2352 x 1568 pixels, fundus photo, 45° FOV
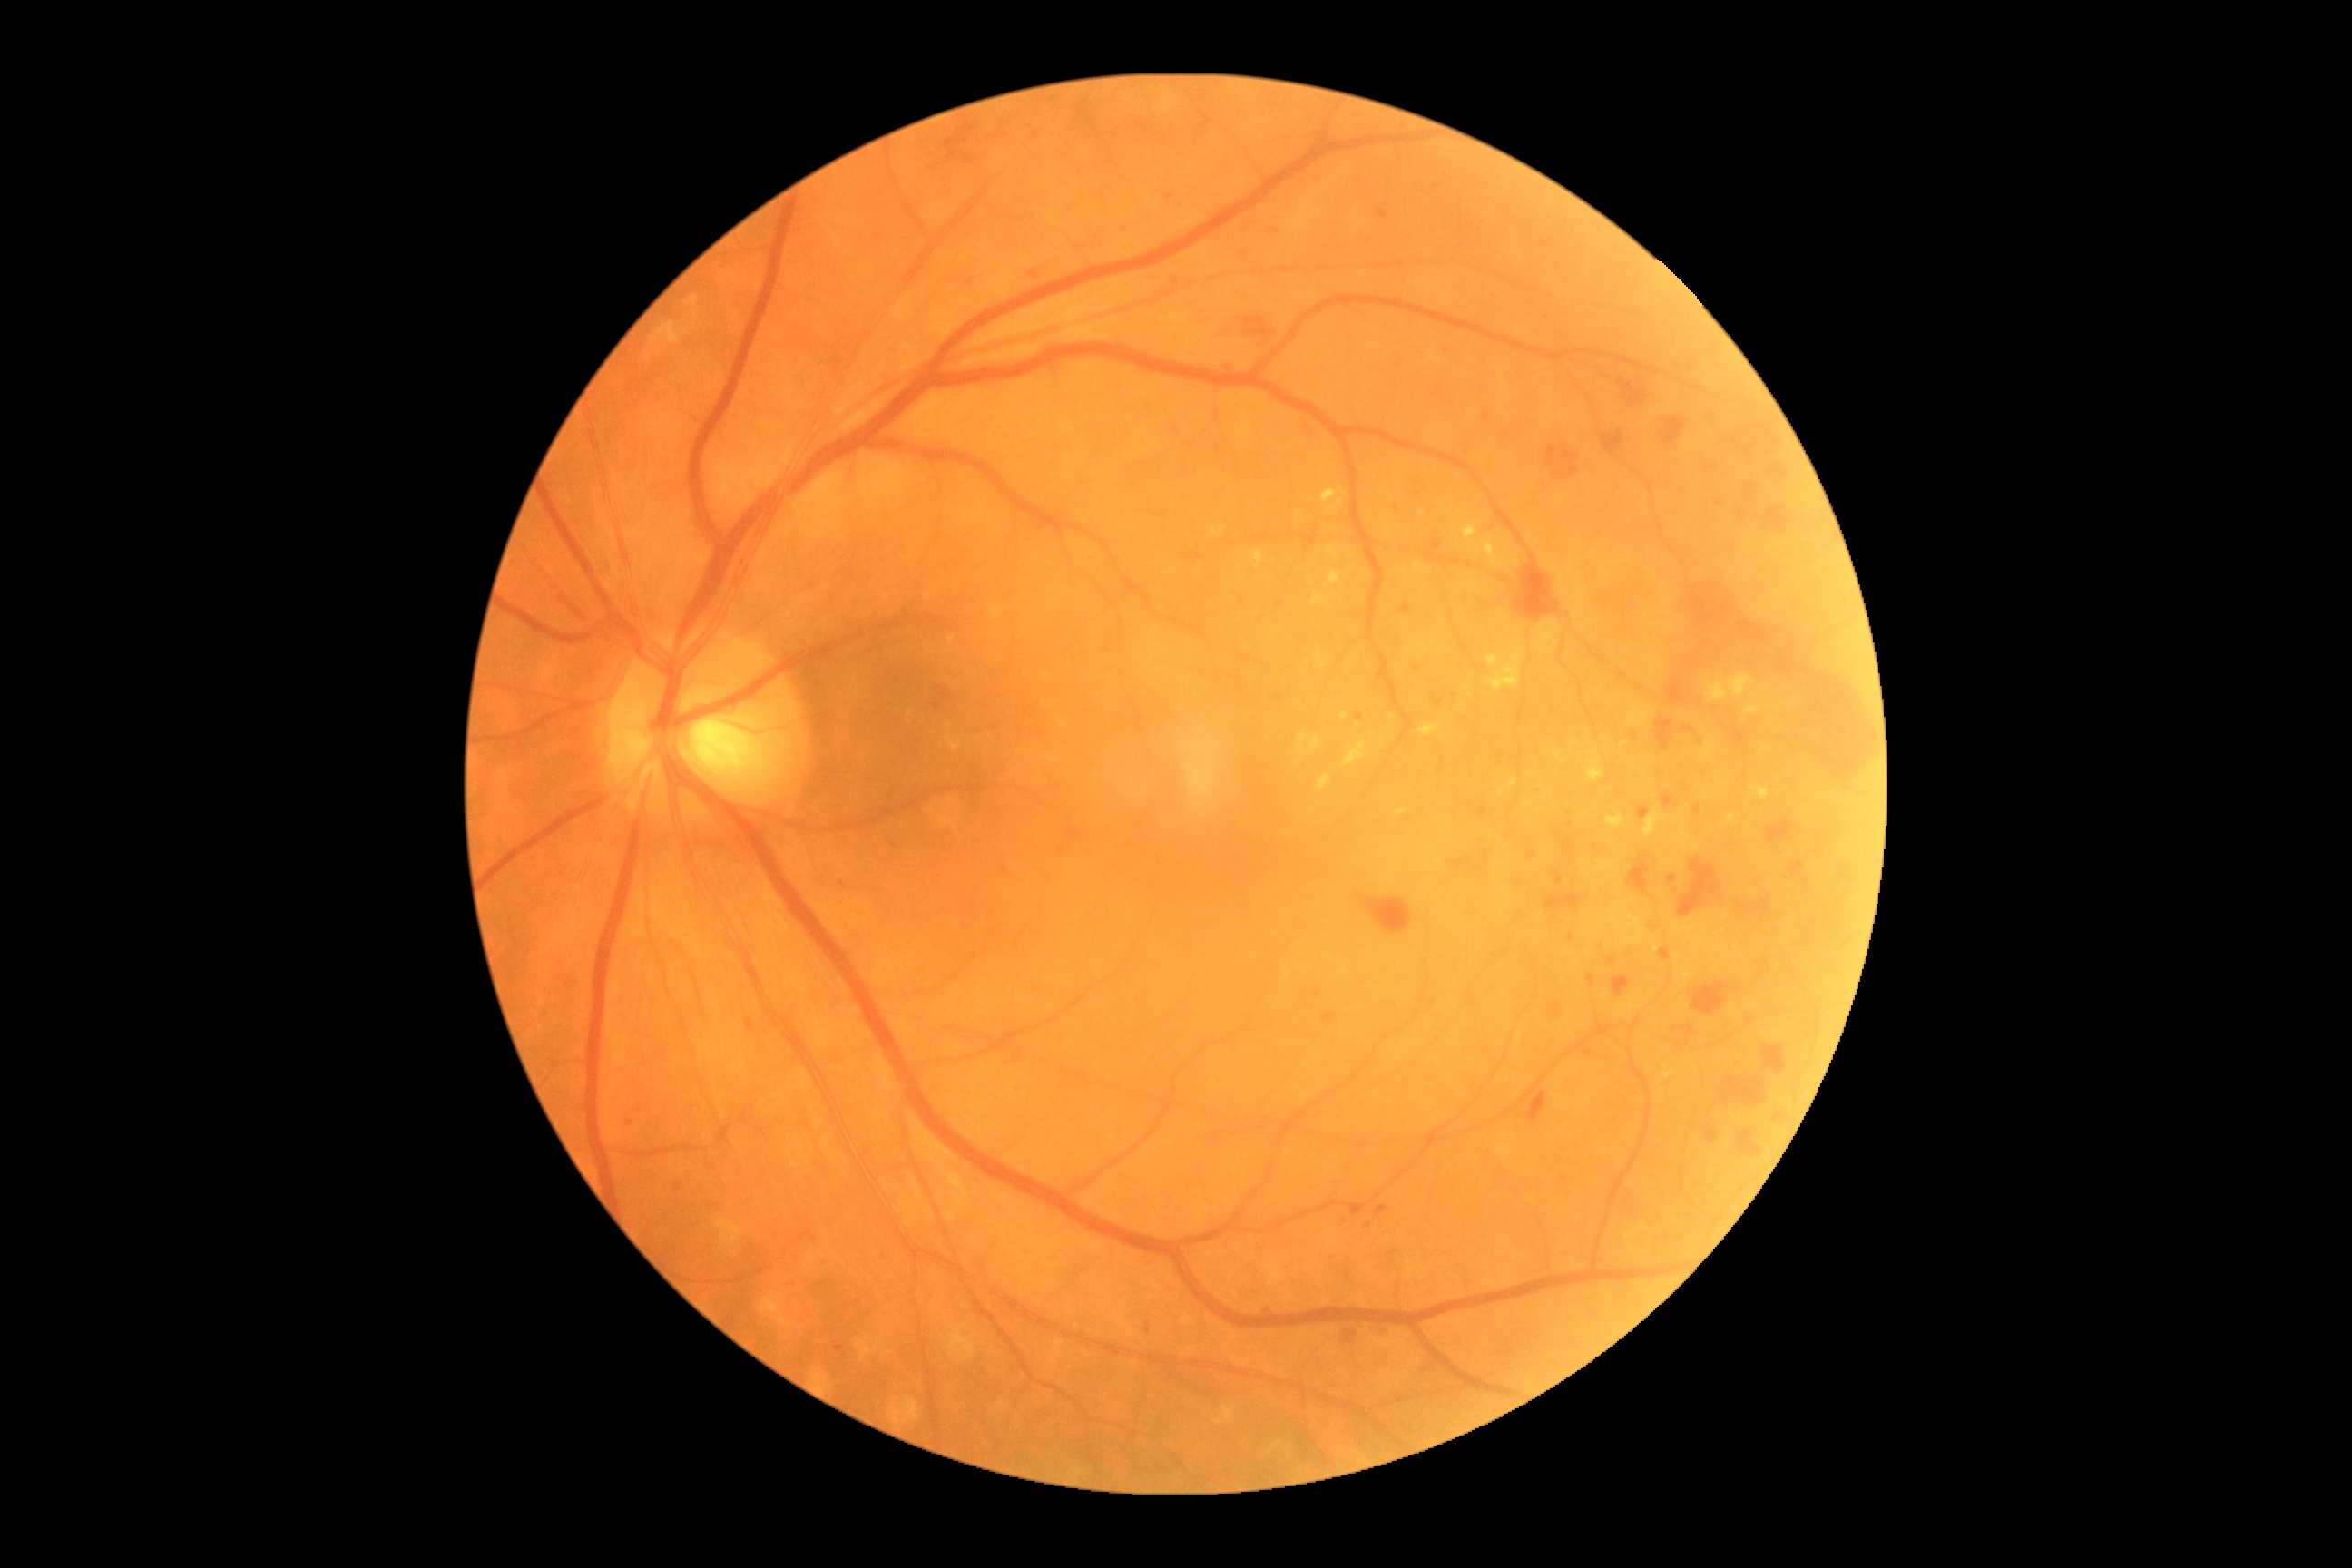 Disease class: non-proliferative diabetic retinopathy. Retinopathy: severe NPDR (grade 3).